DR severity per modified Davis staging; NIDEK AFC-230 fundus camera; 848x848px.
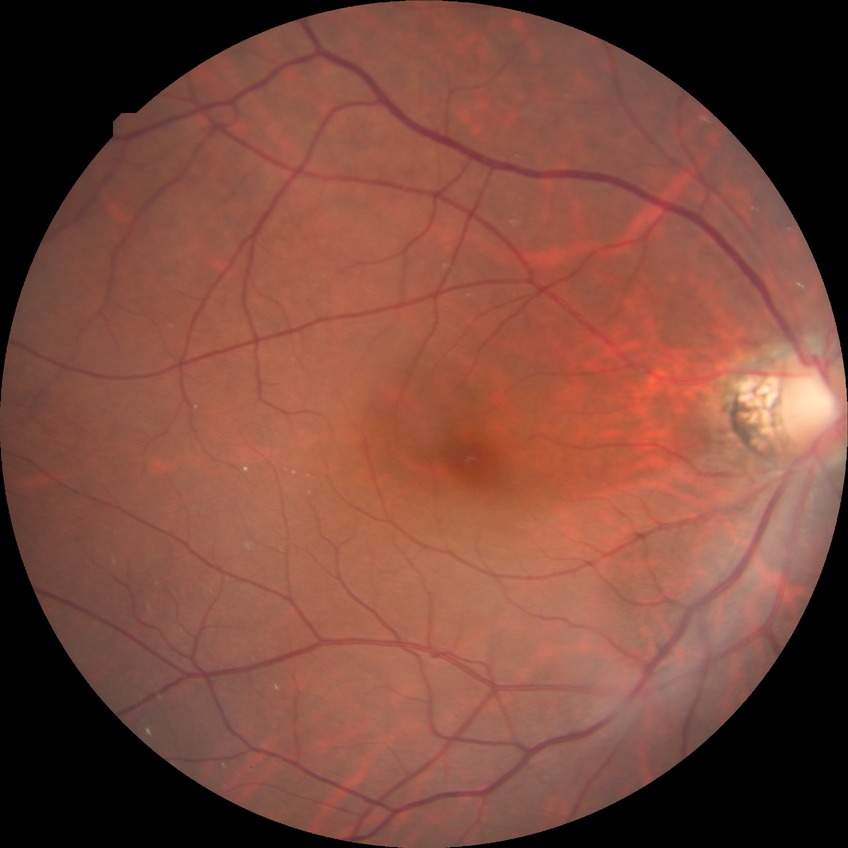 Diabetic retinopathy (DR) is no diabetic retinopathy (NDR).